Fundus photo. 45° field of view. 2352x1568: 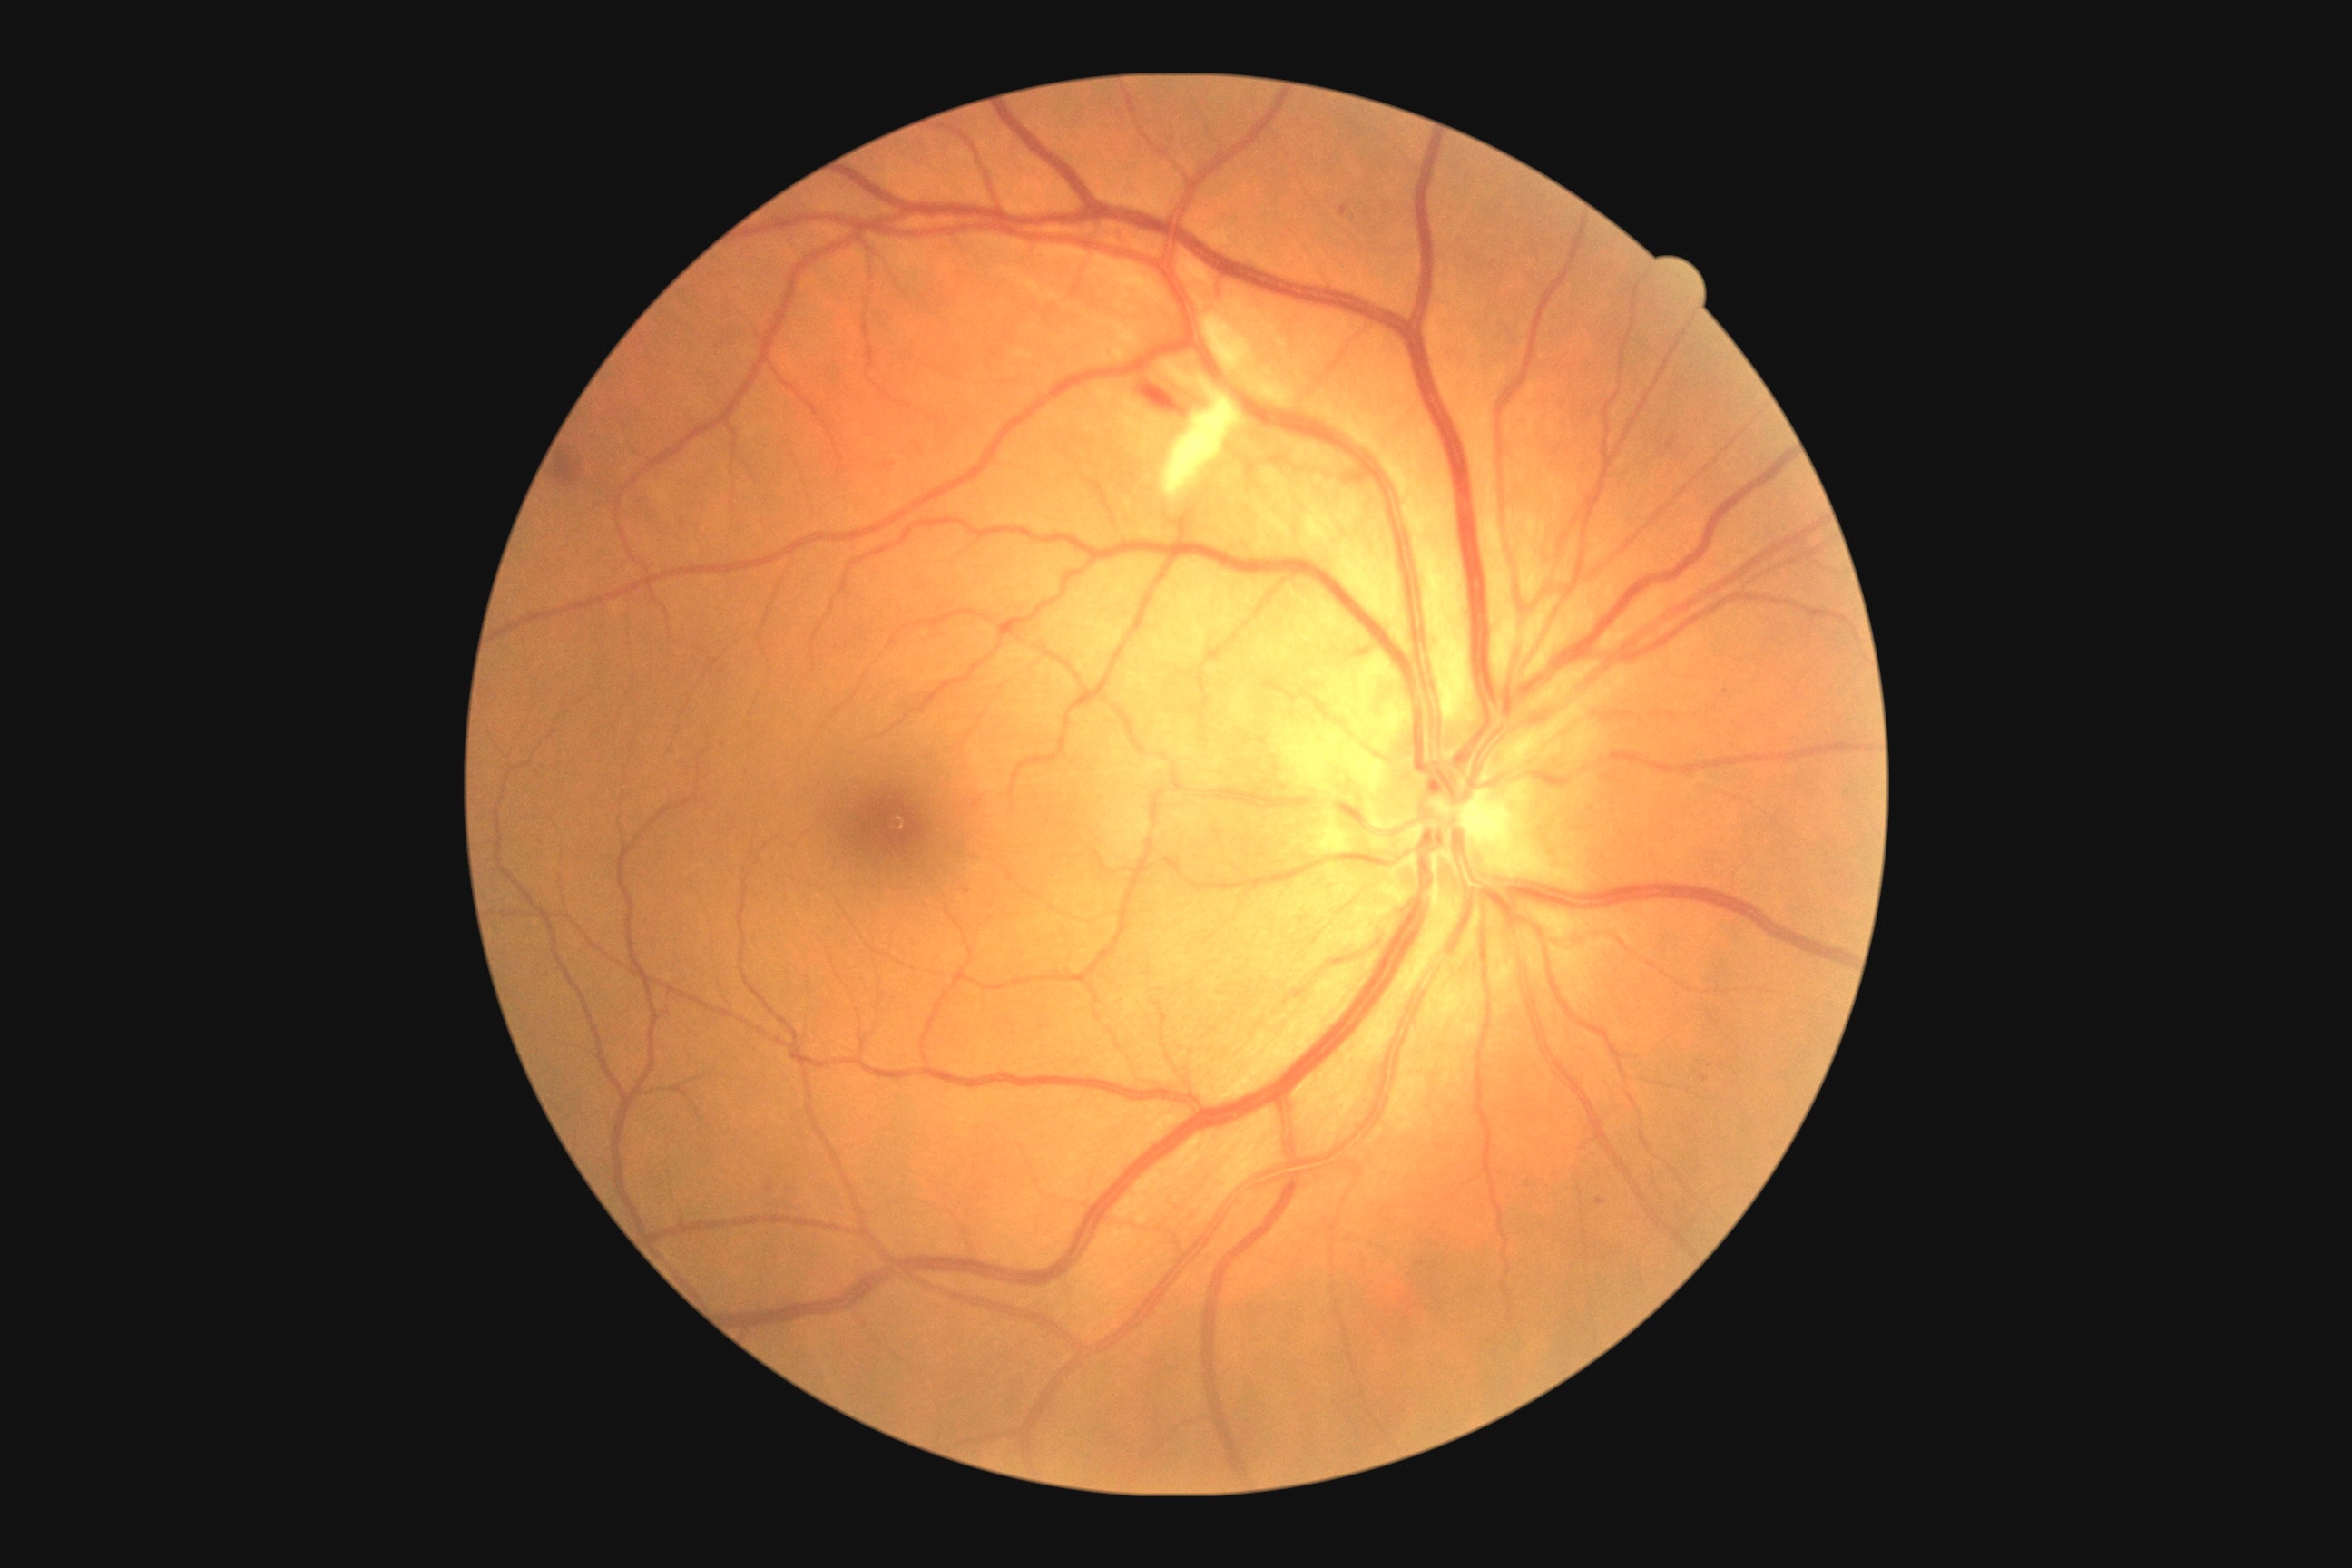

{"dr_grade": 2, "dr_grade_name": "moderate NPDR", "lesions": {"ex": null, "ma": [[1701, 1077, 1709, 1083], [1596, 1199, 1605, 1206], [1340, 206, 1349, 217]], "ma_small": [[770, 1188], [1710, 1066]], "se": [[1170, 402, 1231, 491], [1211, 322, 1253, 371]], "he": [[554, 456, 580, 484], [1137, 386, 1186, 415]]}}